2212x1672.
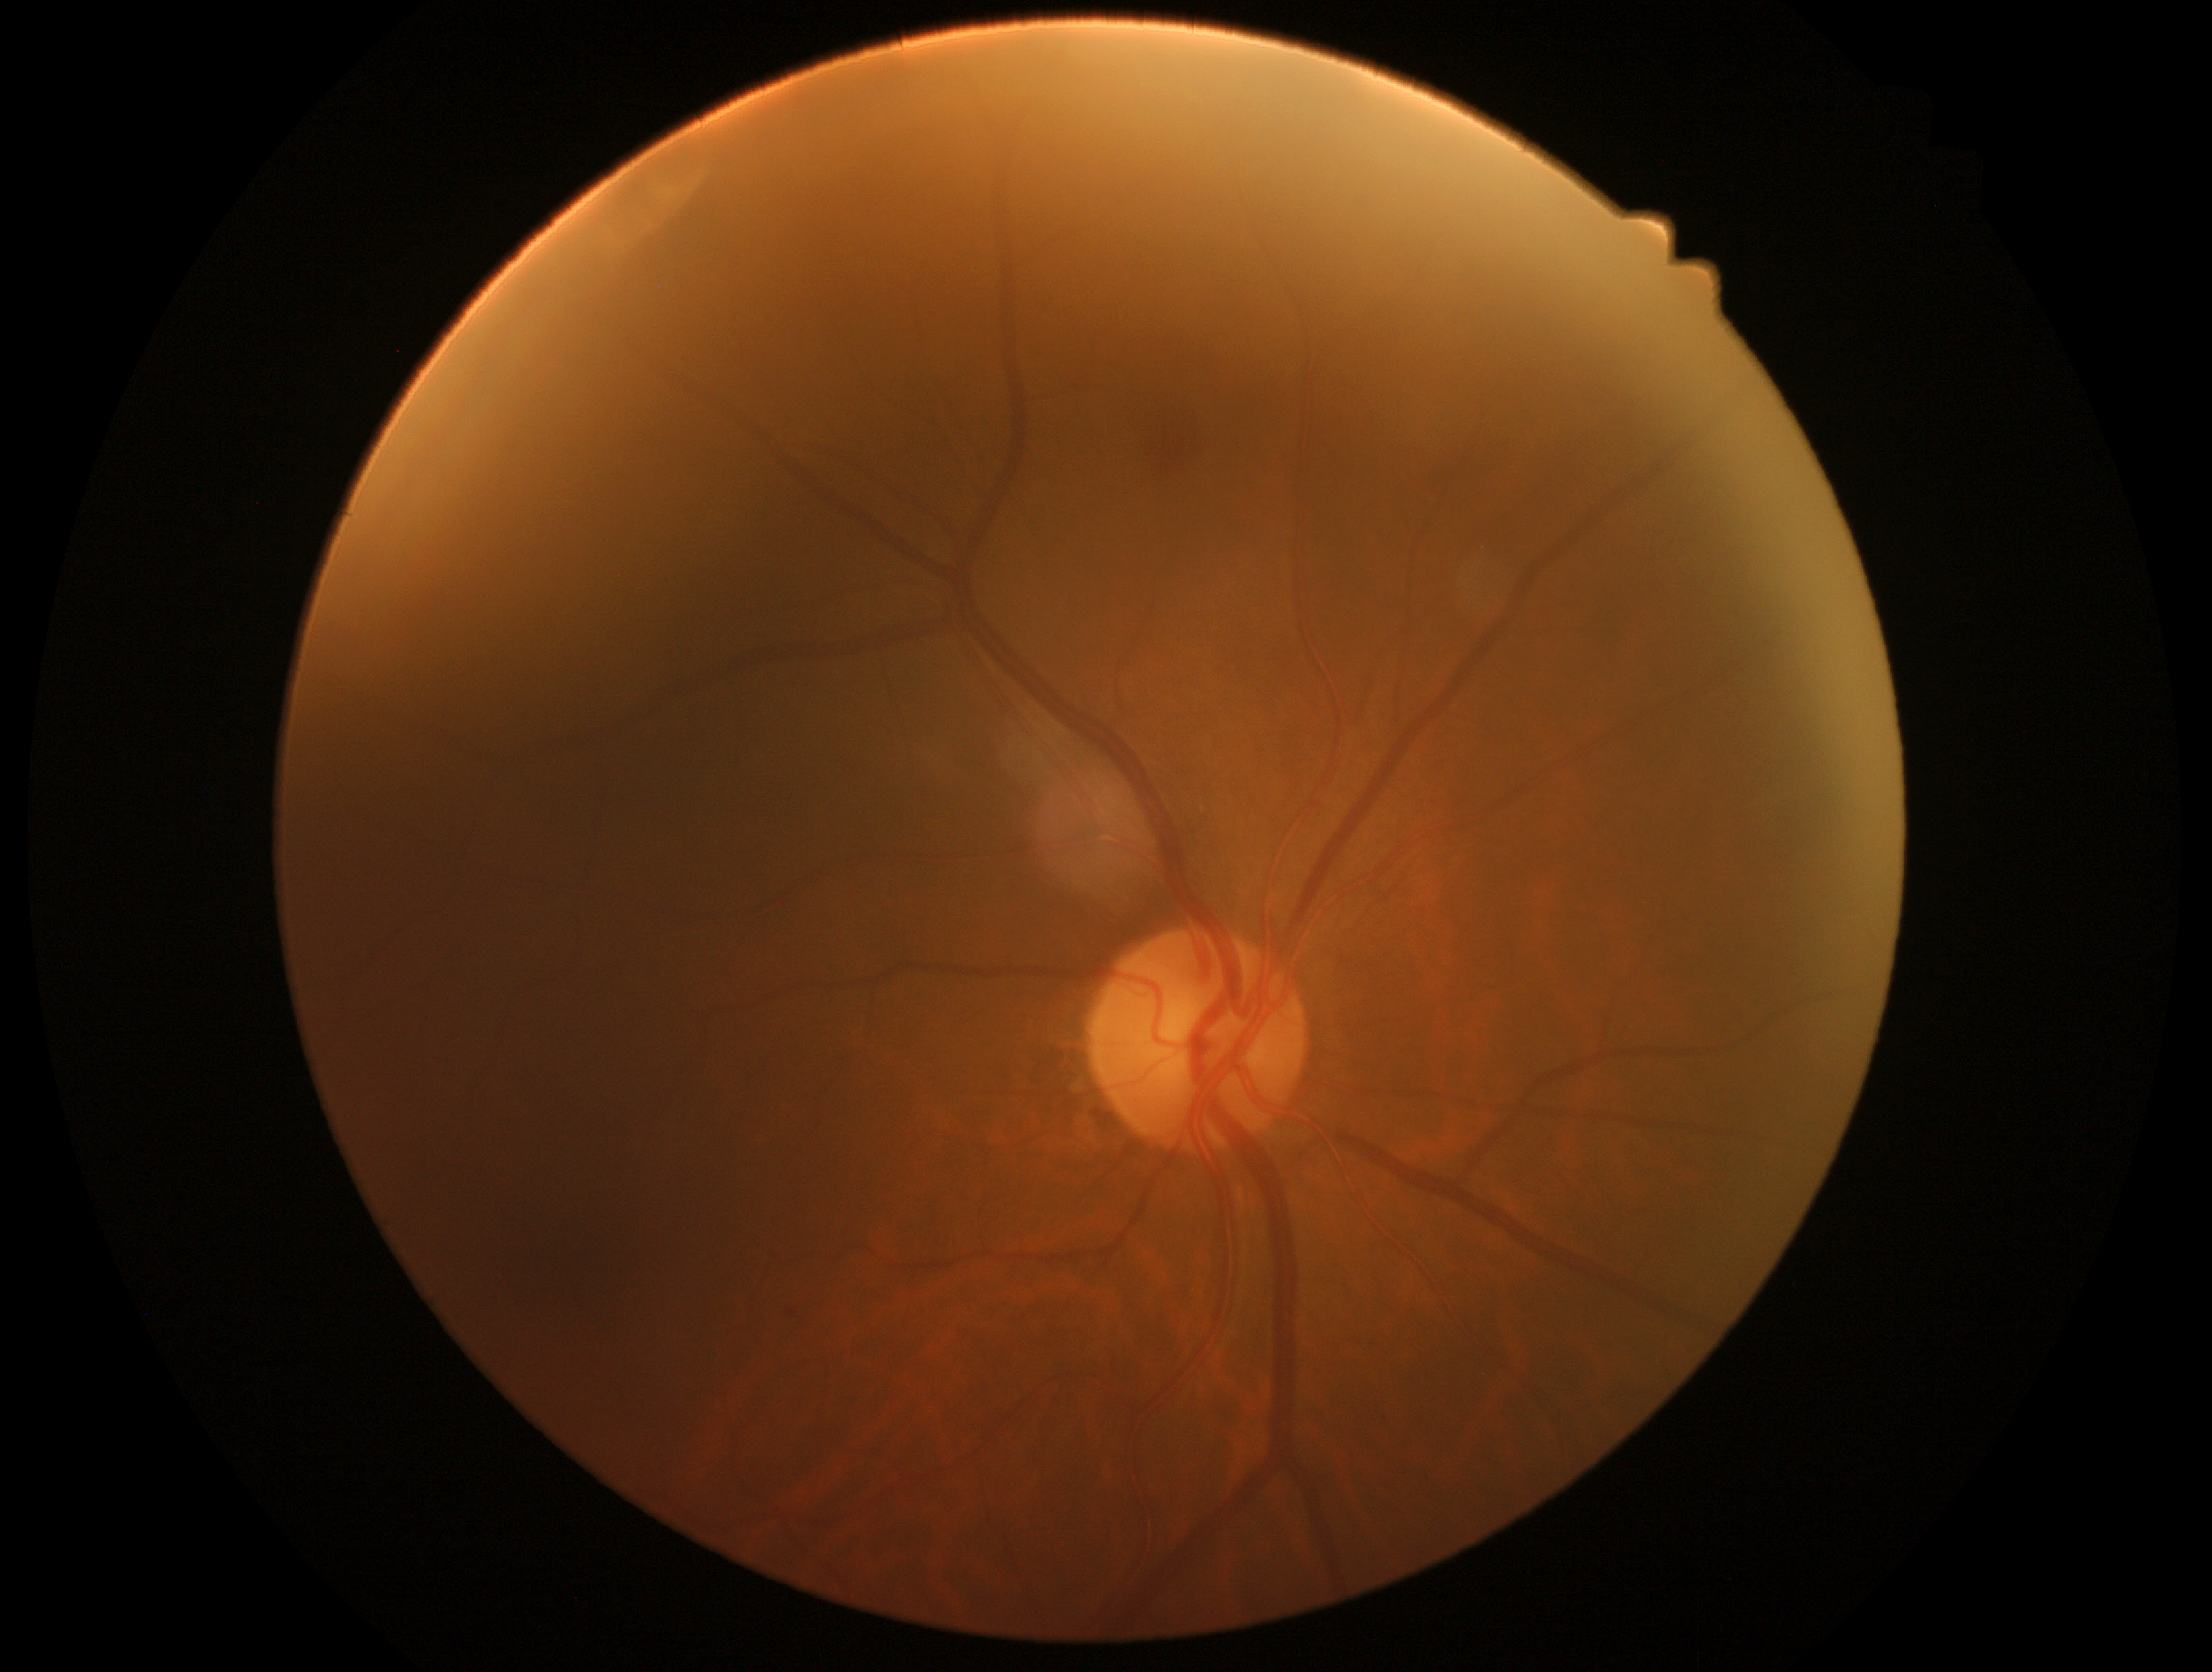

DR grade is 2.